848 x 848 pixels. Without pupil dilation:
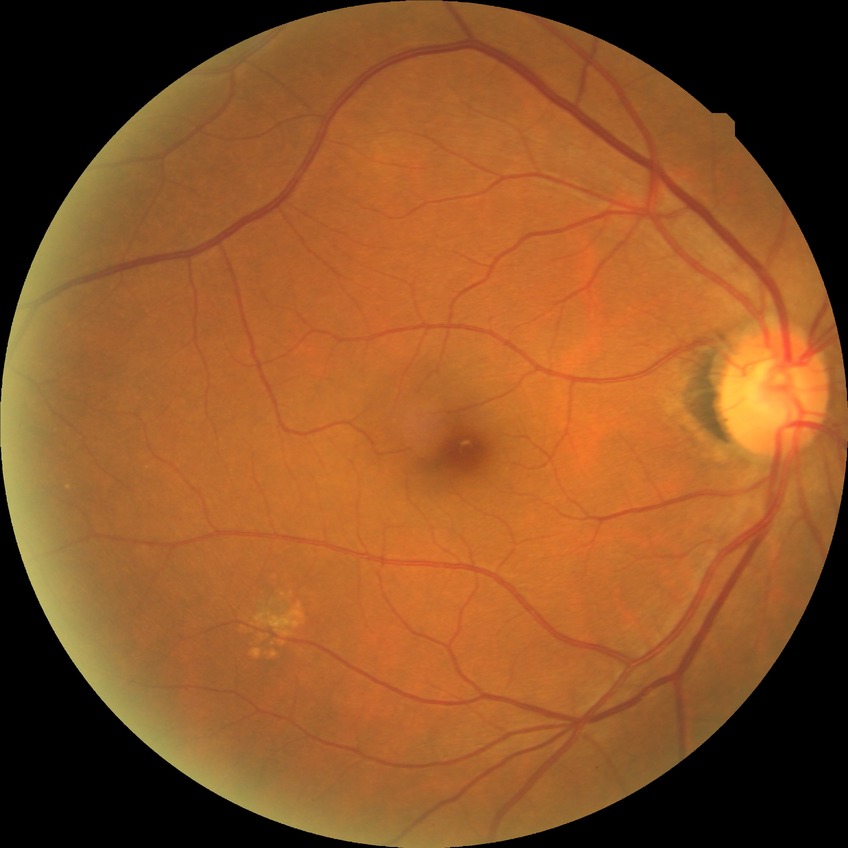
Retinopathy stage: no diabetic retinopathy.